Fundus photo:
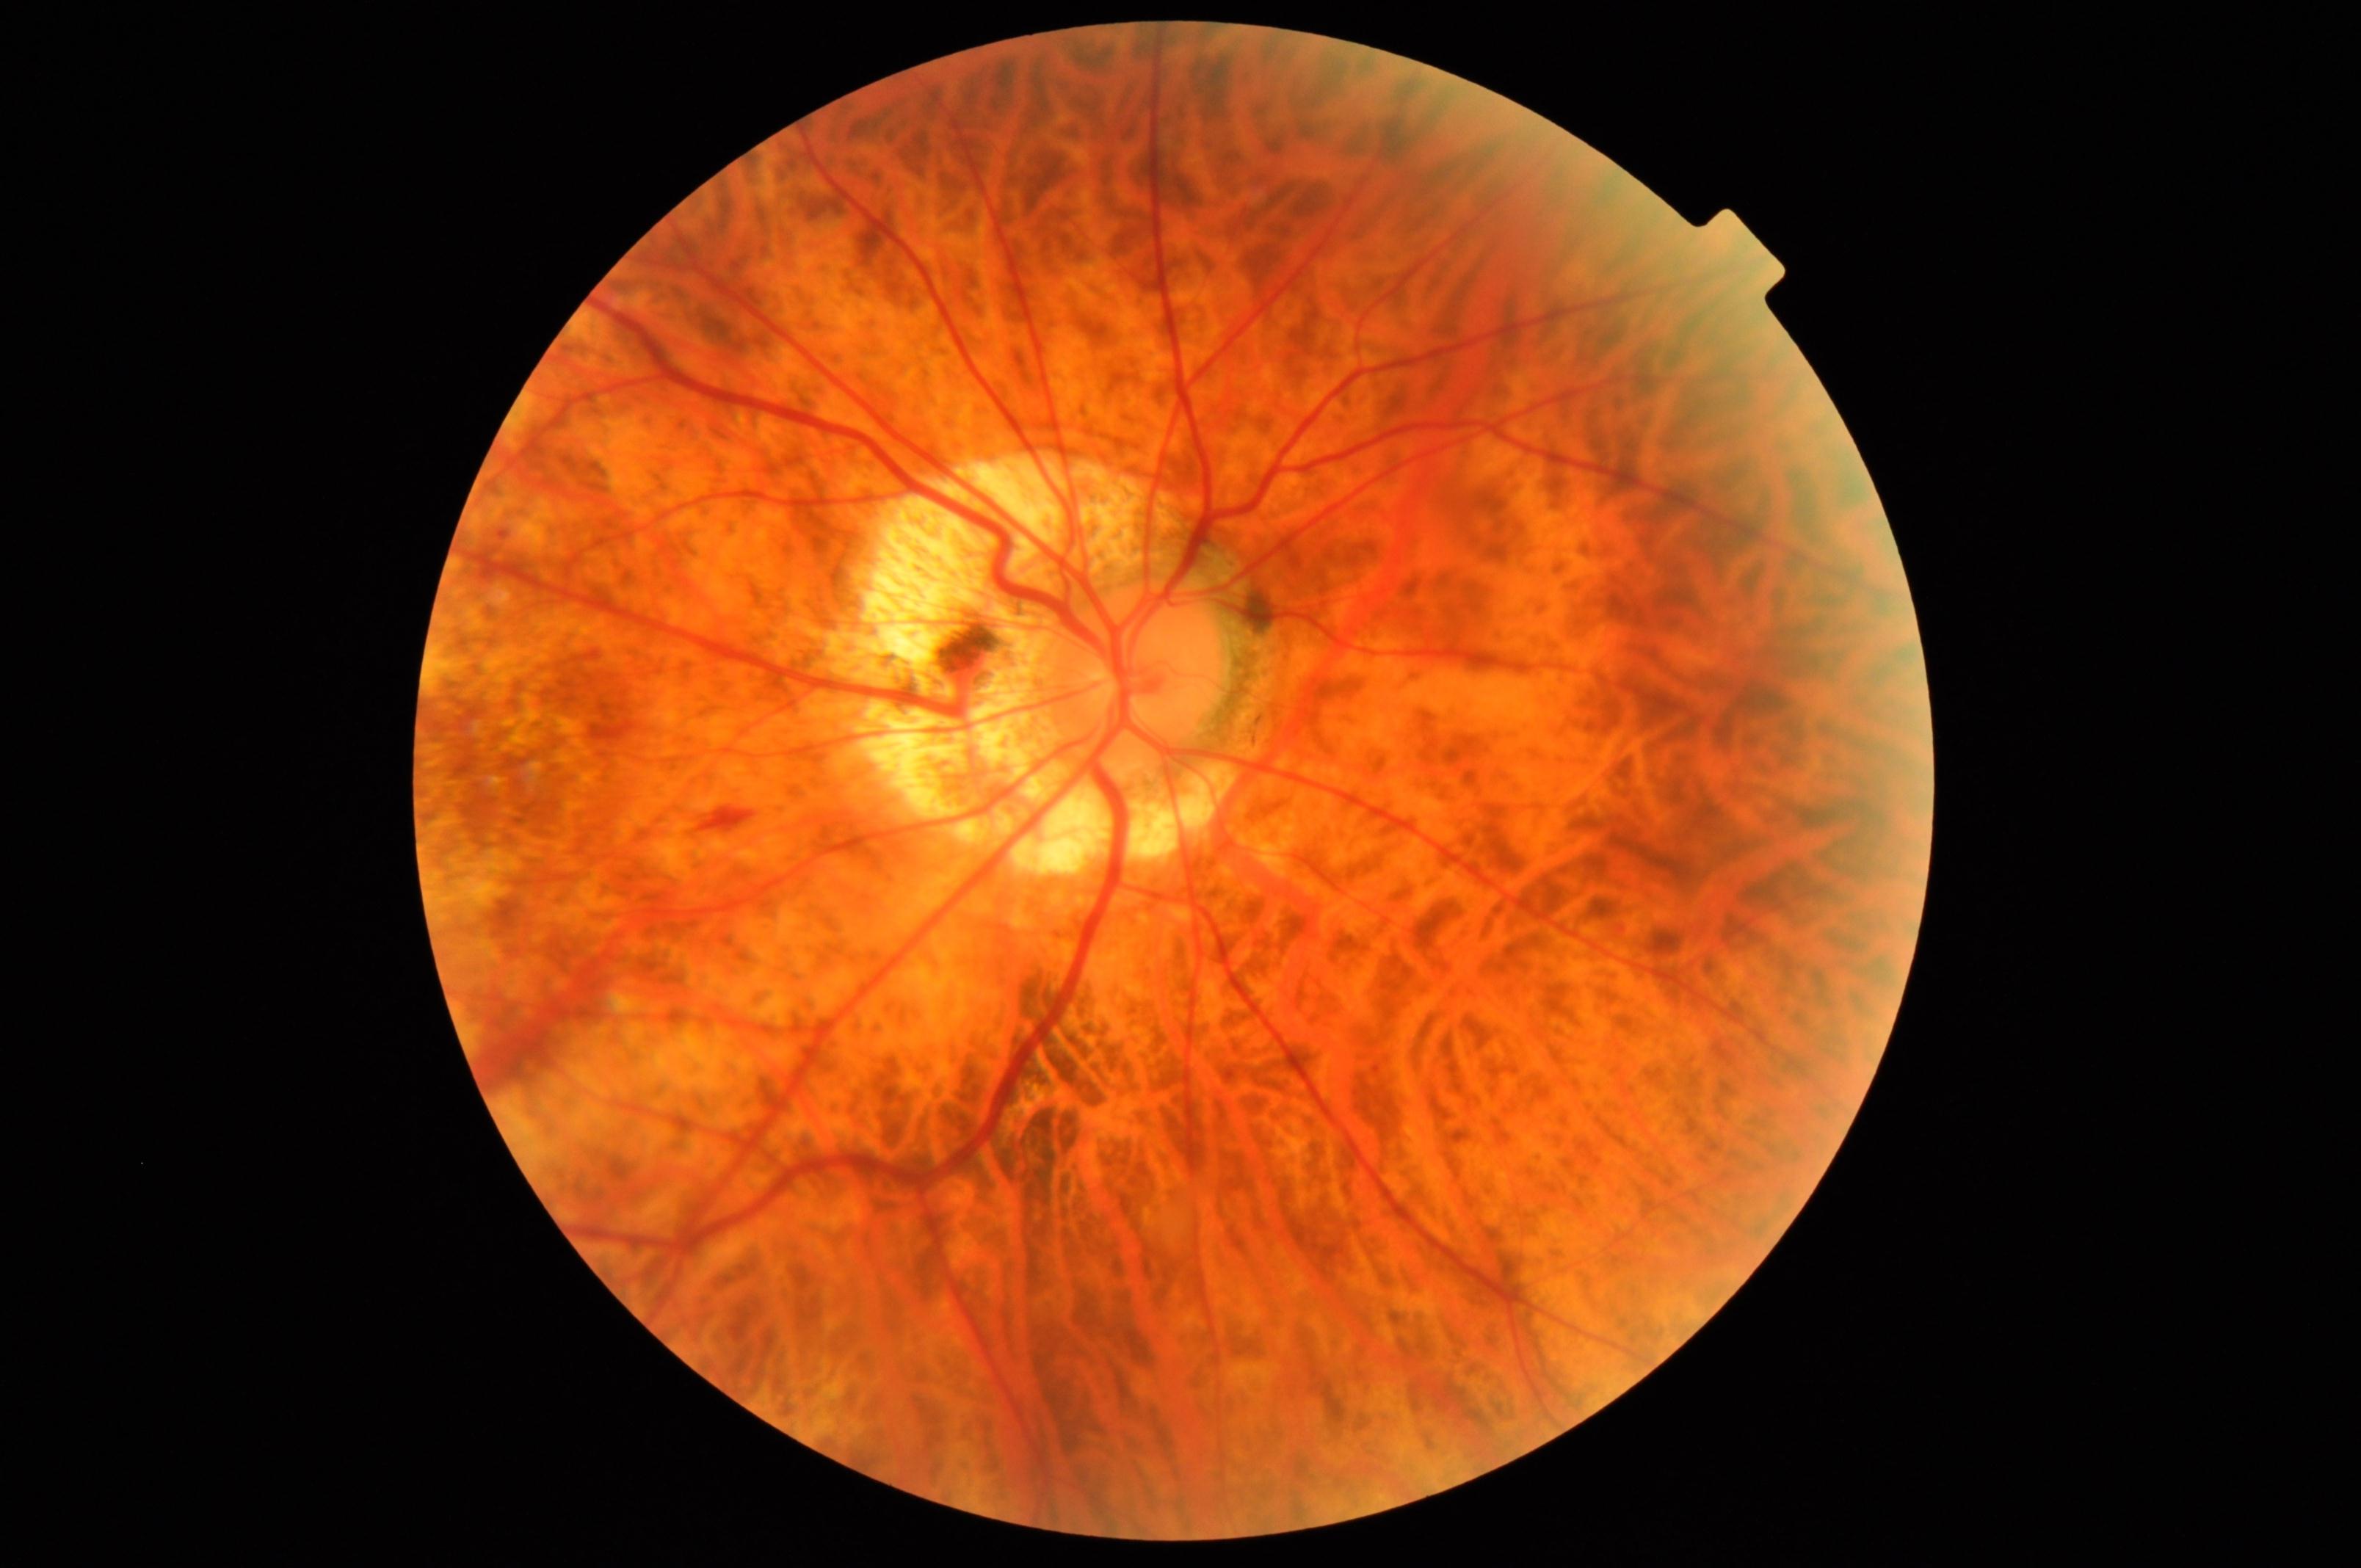 Primary finding: pathological myopia. Typically showing tessellated fundus with focal chorioretinal atrophy, Fuchs spot, lacquer cracks, choroidal neovascularization, or subretinal hemorrhage.